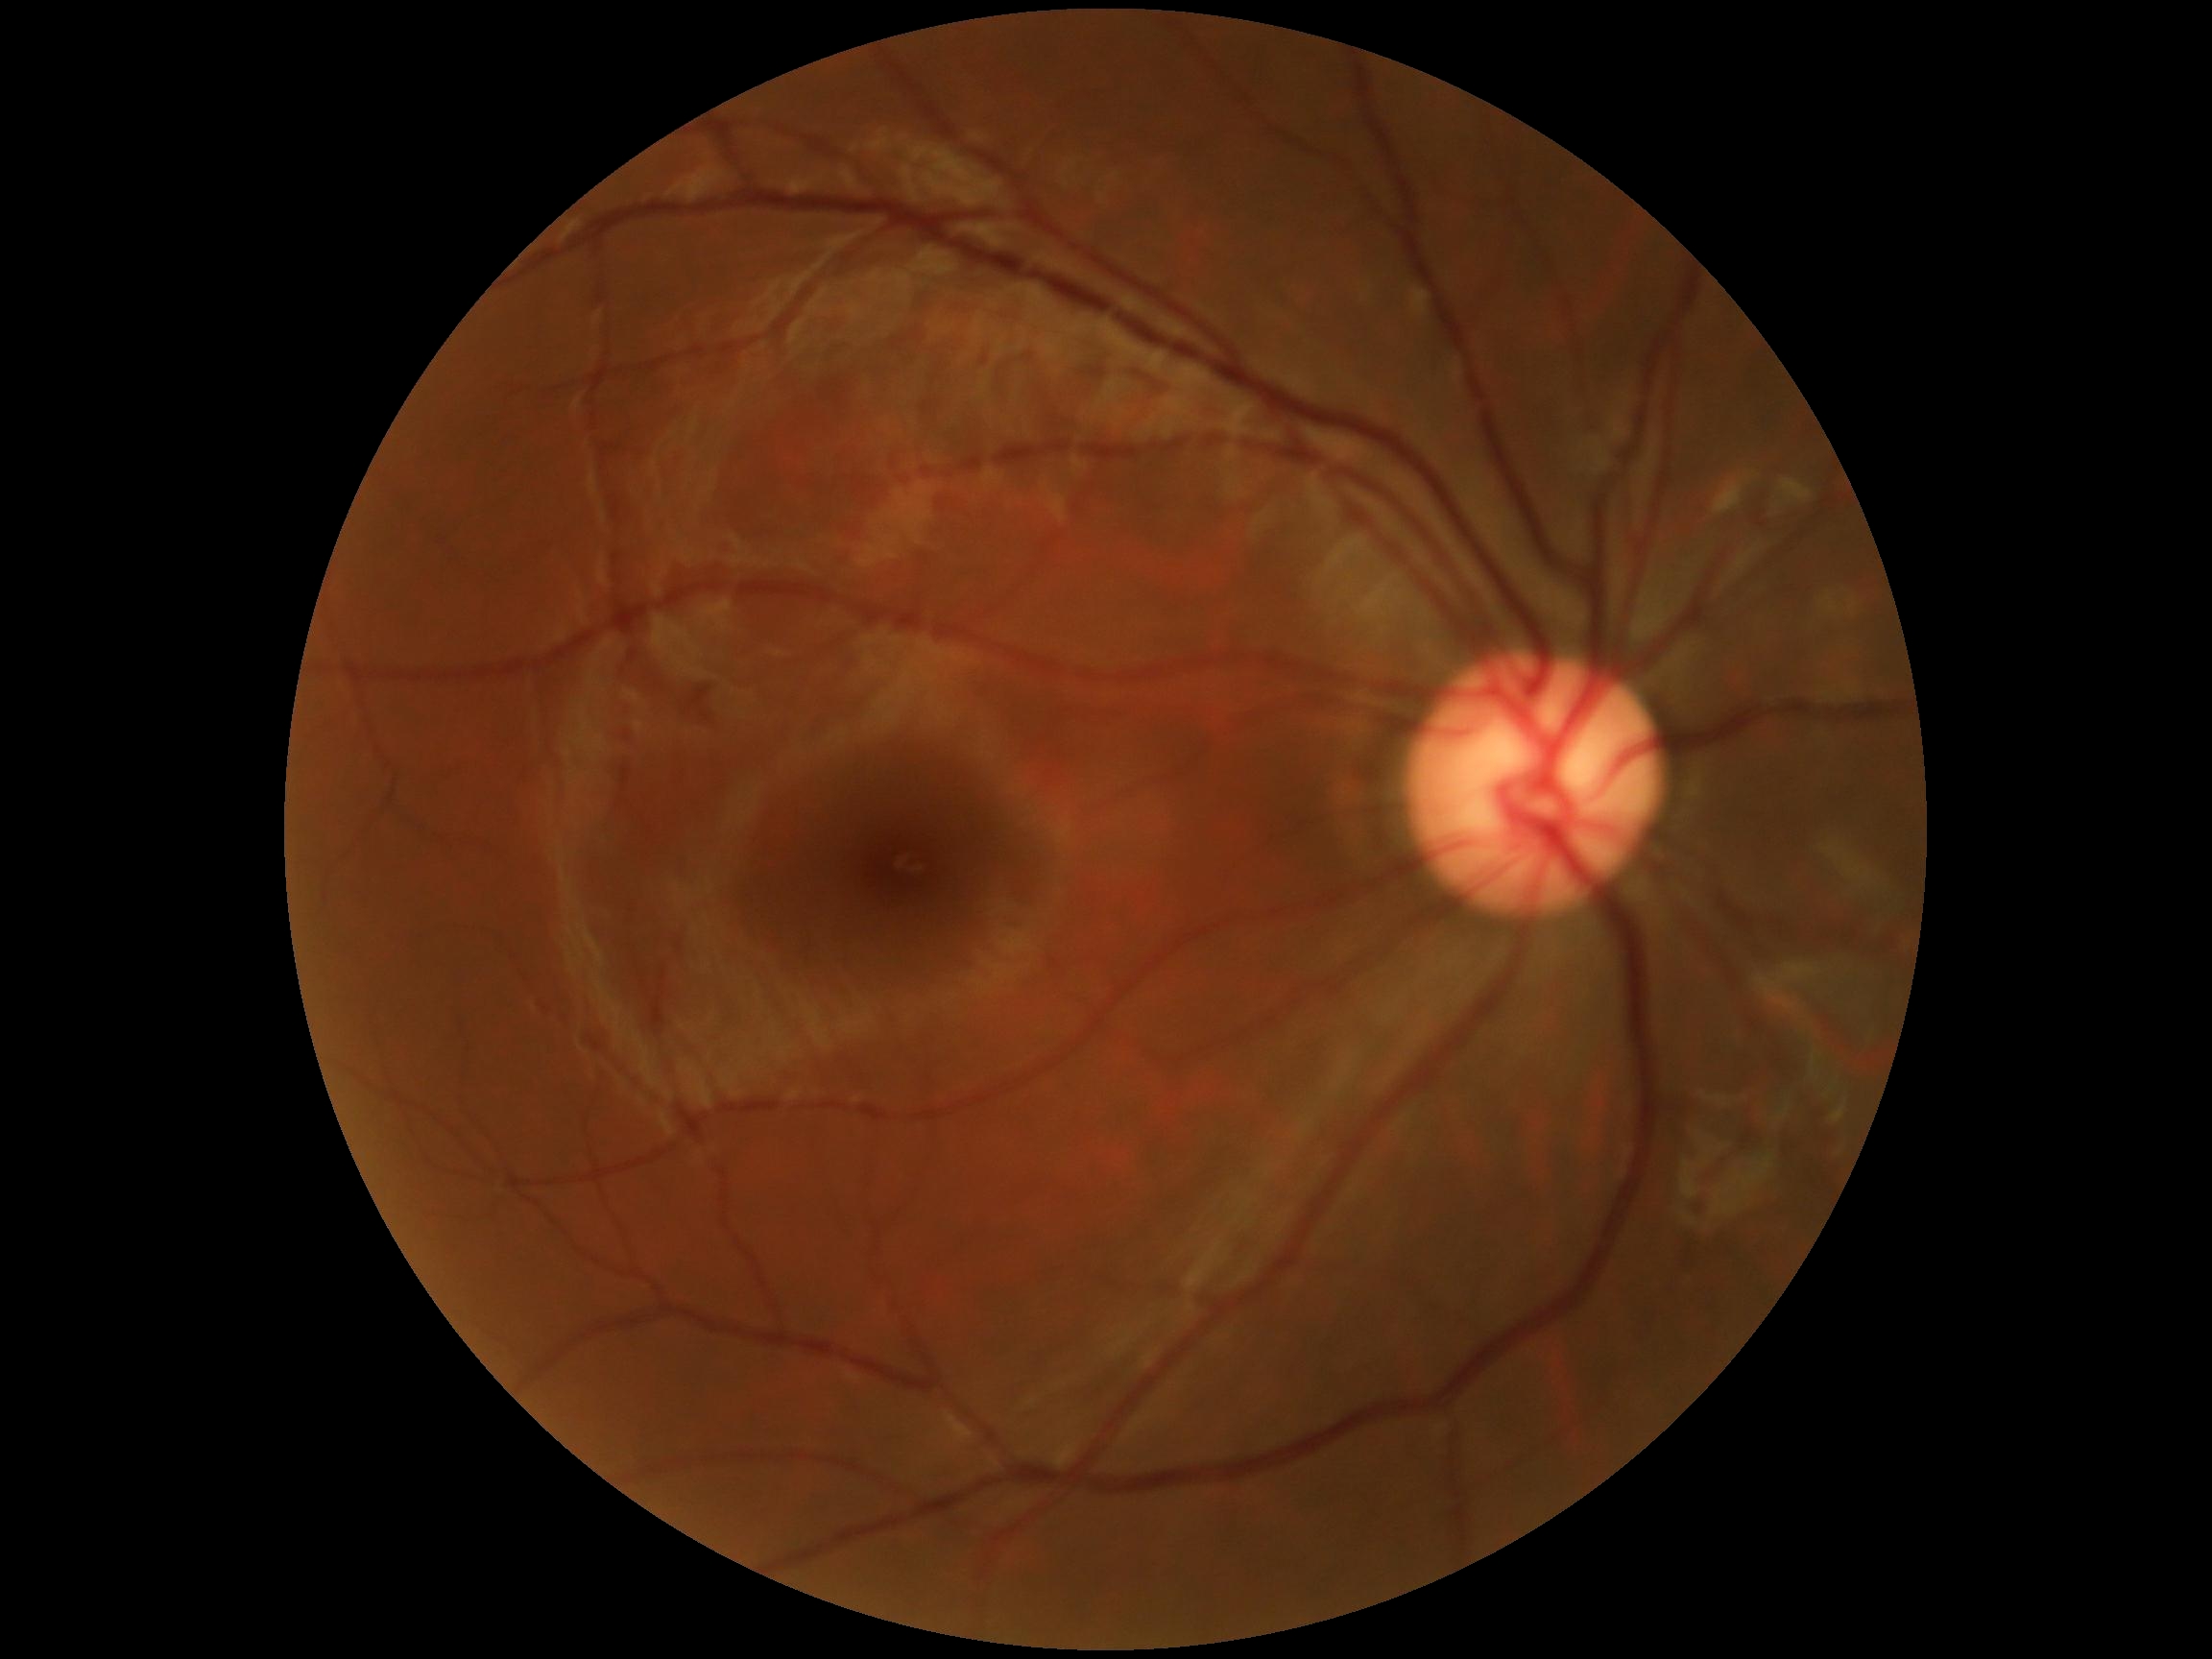

– retinopathy grade — no apparent retinopathy (0)
– DR impression — no DR findings